Acquired with a NIDEK AFC-230. Retinal fundus photograph: 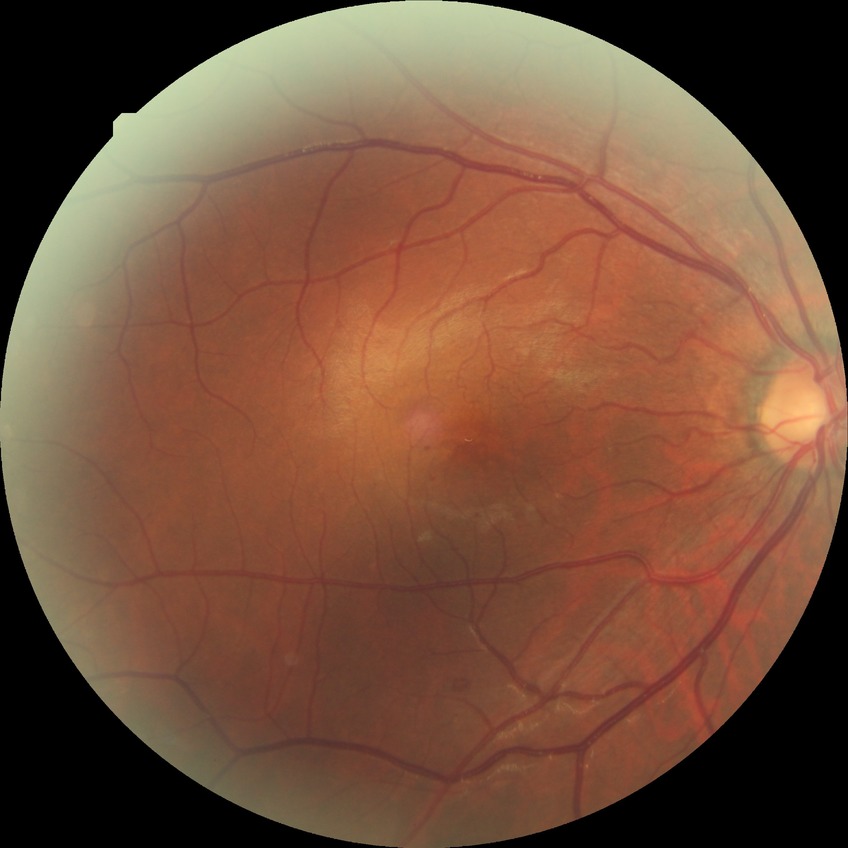
retinopathy stage = simple diabetic retinopathy